FOV: 45 degrees, 2346 x 1568 pixels, color fundus image:
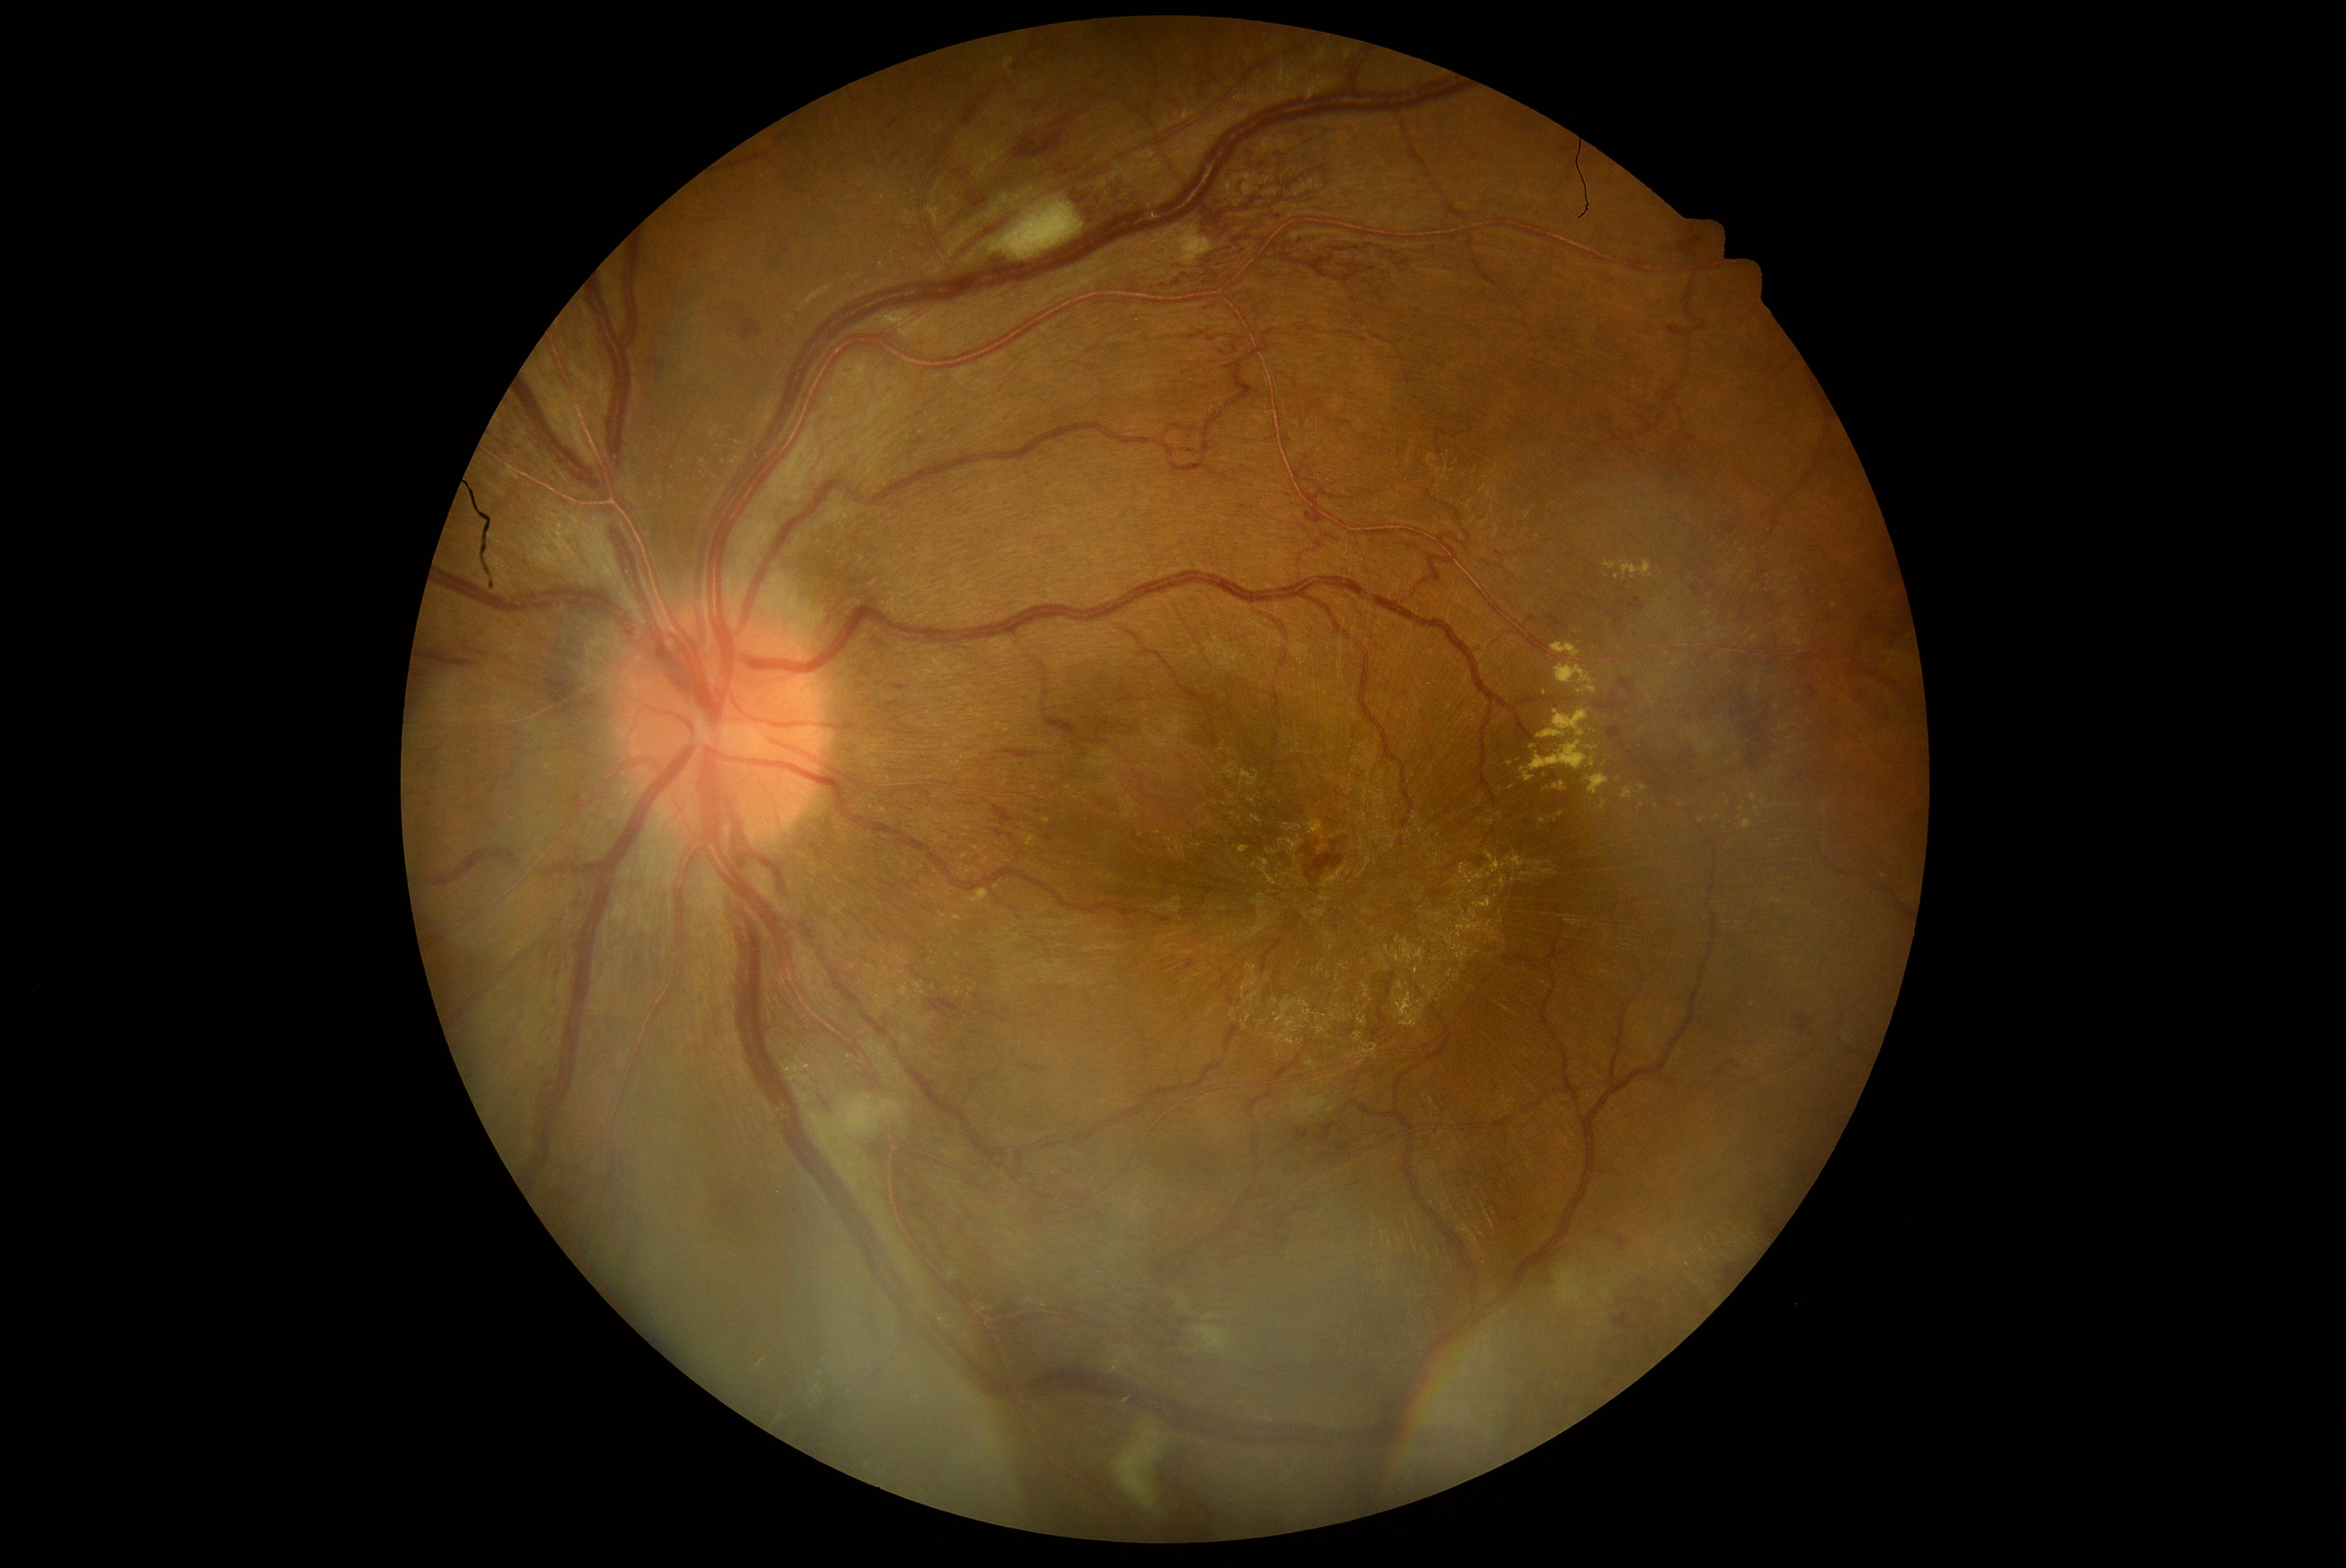

Diabetic retinopathy (DR) is grade 3 (severe NPDR)
A subset of detected lesions:
* hemorrhages (HEs) (continued): (1661, 777, 1672, 782) | (1051, 161, 1078, 181) | (1238, 1183, 1312, 1261) | (1189, 74, 1218, 106) | (741, 321, 763, 341) | (570, 333, 594, 358) | (732, 307, 744, 318) | (953, 170, 965, 180) | (1020, 1064, 1045, 1075) | (1627, 598, 1641, 611) | (1614, 1296, 1658, 1313) | (890, 120, 898, 129) | (1690, 584, 1705, 598) | (1163, 92, 1180, 112)
* HEs (small, approximate centers) near (1631; 536) | (1692; 769) | (1666; 785) | (650; 362) | (1054; 127) | (1702; 781)